CFP: 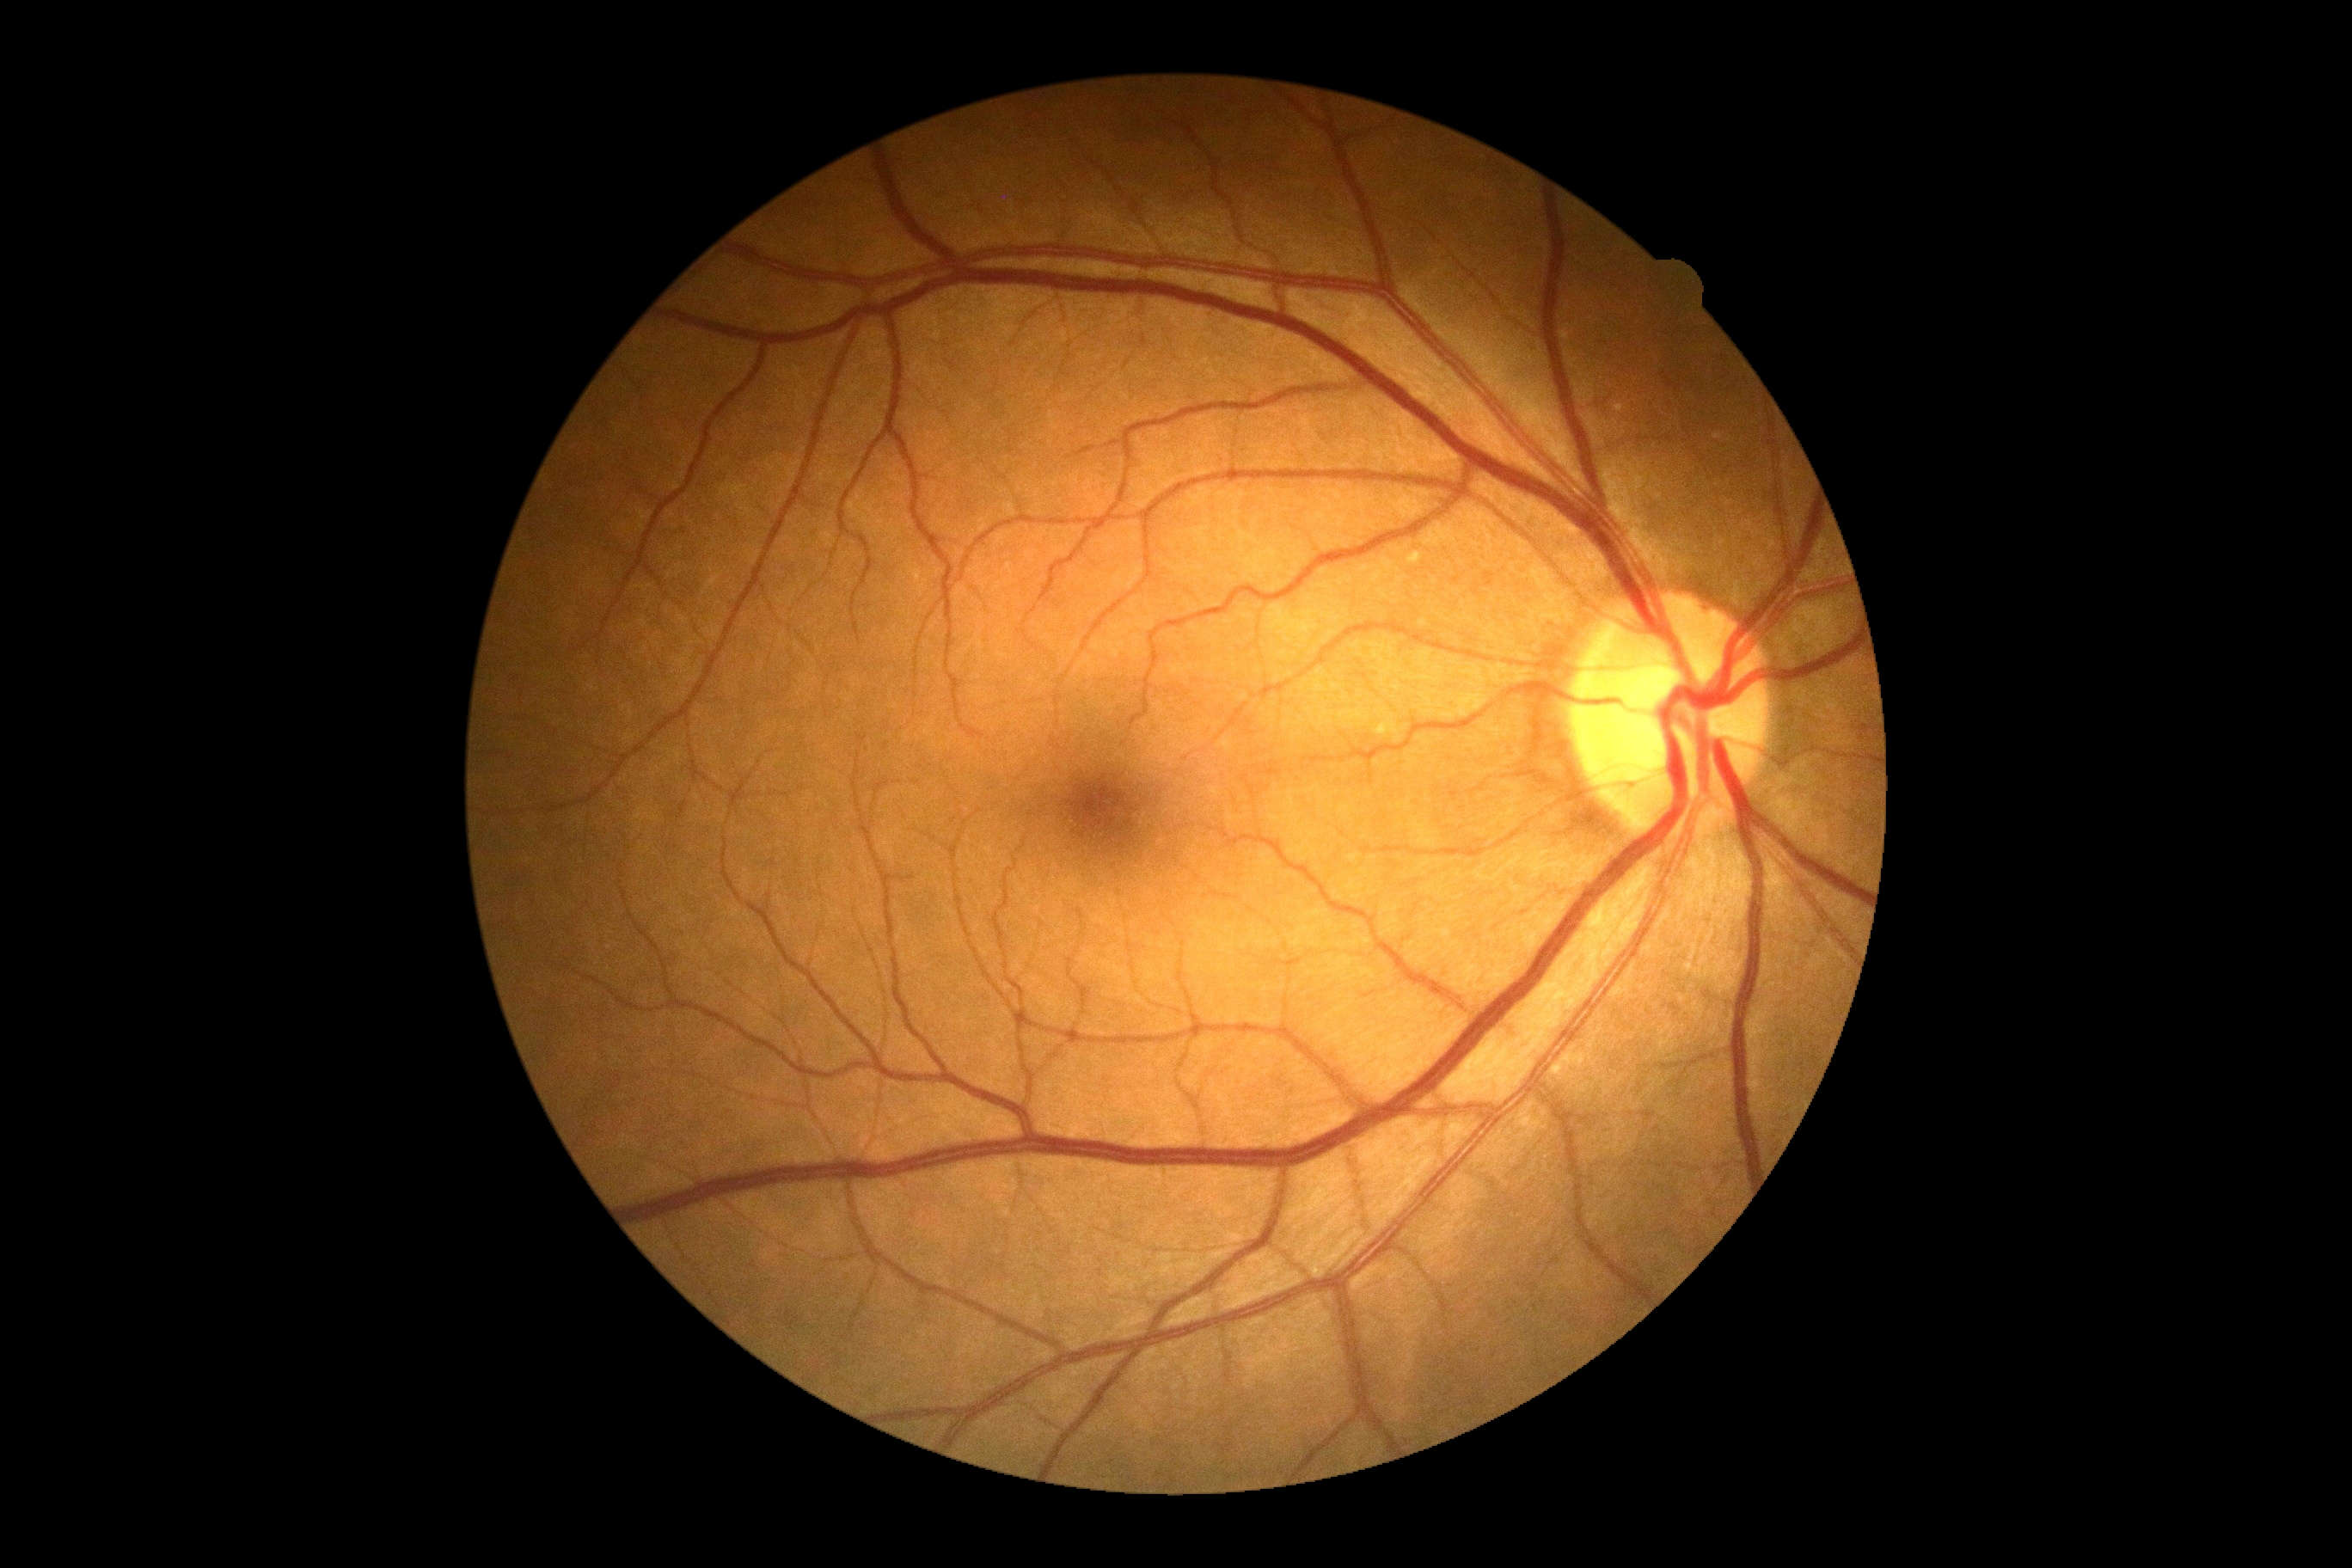 dr_grade: no apparent diabetic retinopathy (grade 0) — no visible signs of diabetic retinopathy